848 x 848 pixels, 45 degree fundus photograph, nonmydriatic, CFP.
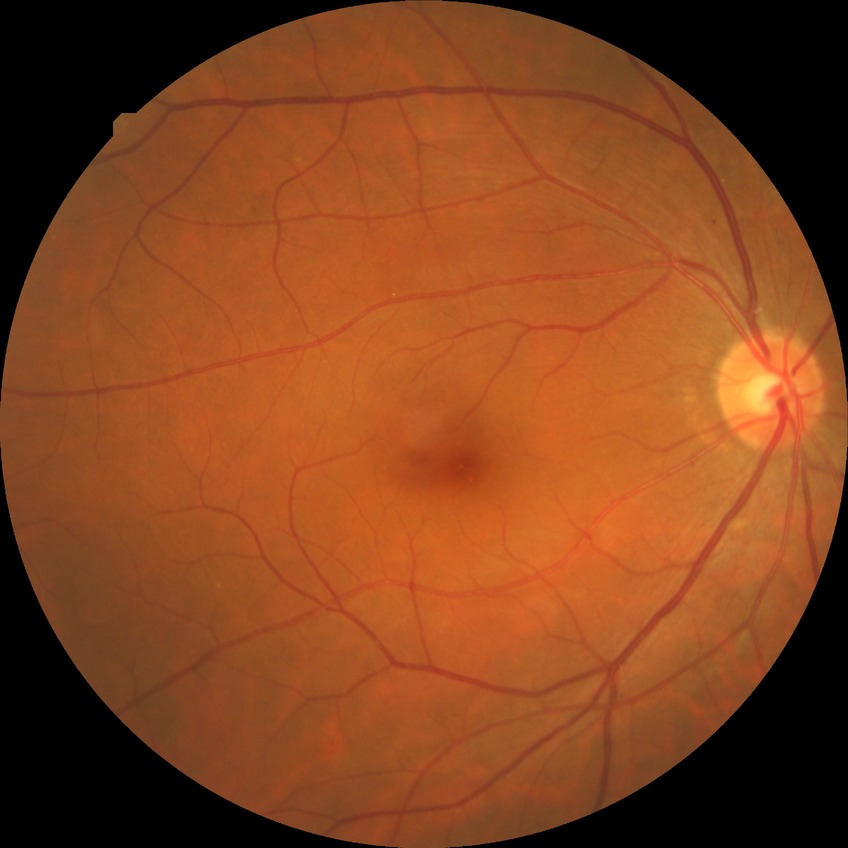

diabetic retinopathy (DR): SDR (simple diabetic retinopathy); DR class: non-proliferative diabetic retinopathy.